640 x 480 pixels · captured with the Clarity RetCam 3 (130° field of view) · RetCam wide-field infant fundus image — 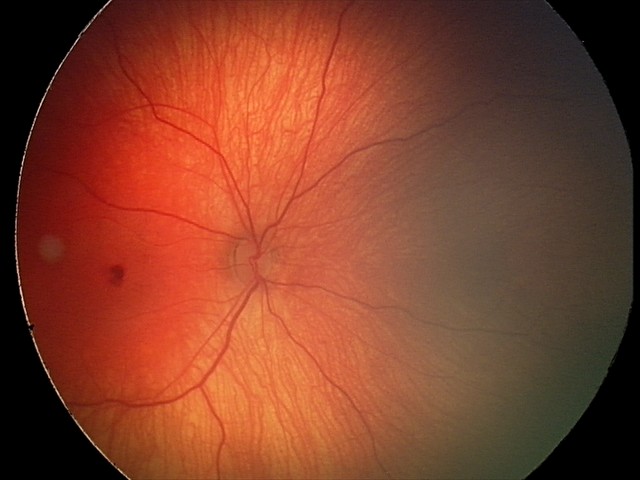 Screening examination consistent with retinal hemorrhages.